Camera: NIDEK AFC-230, color fundus photograph
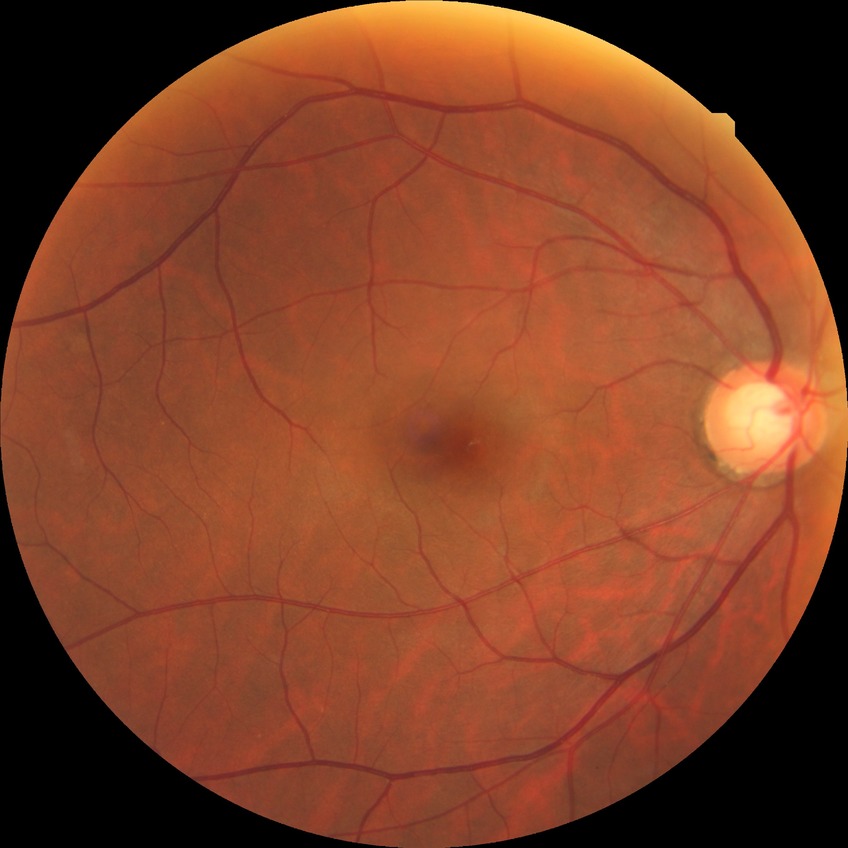
Davis stage: NDR.